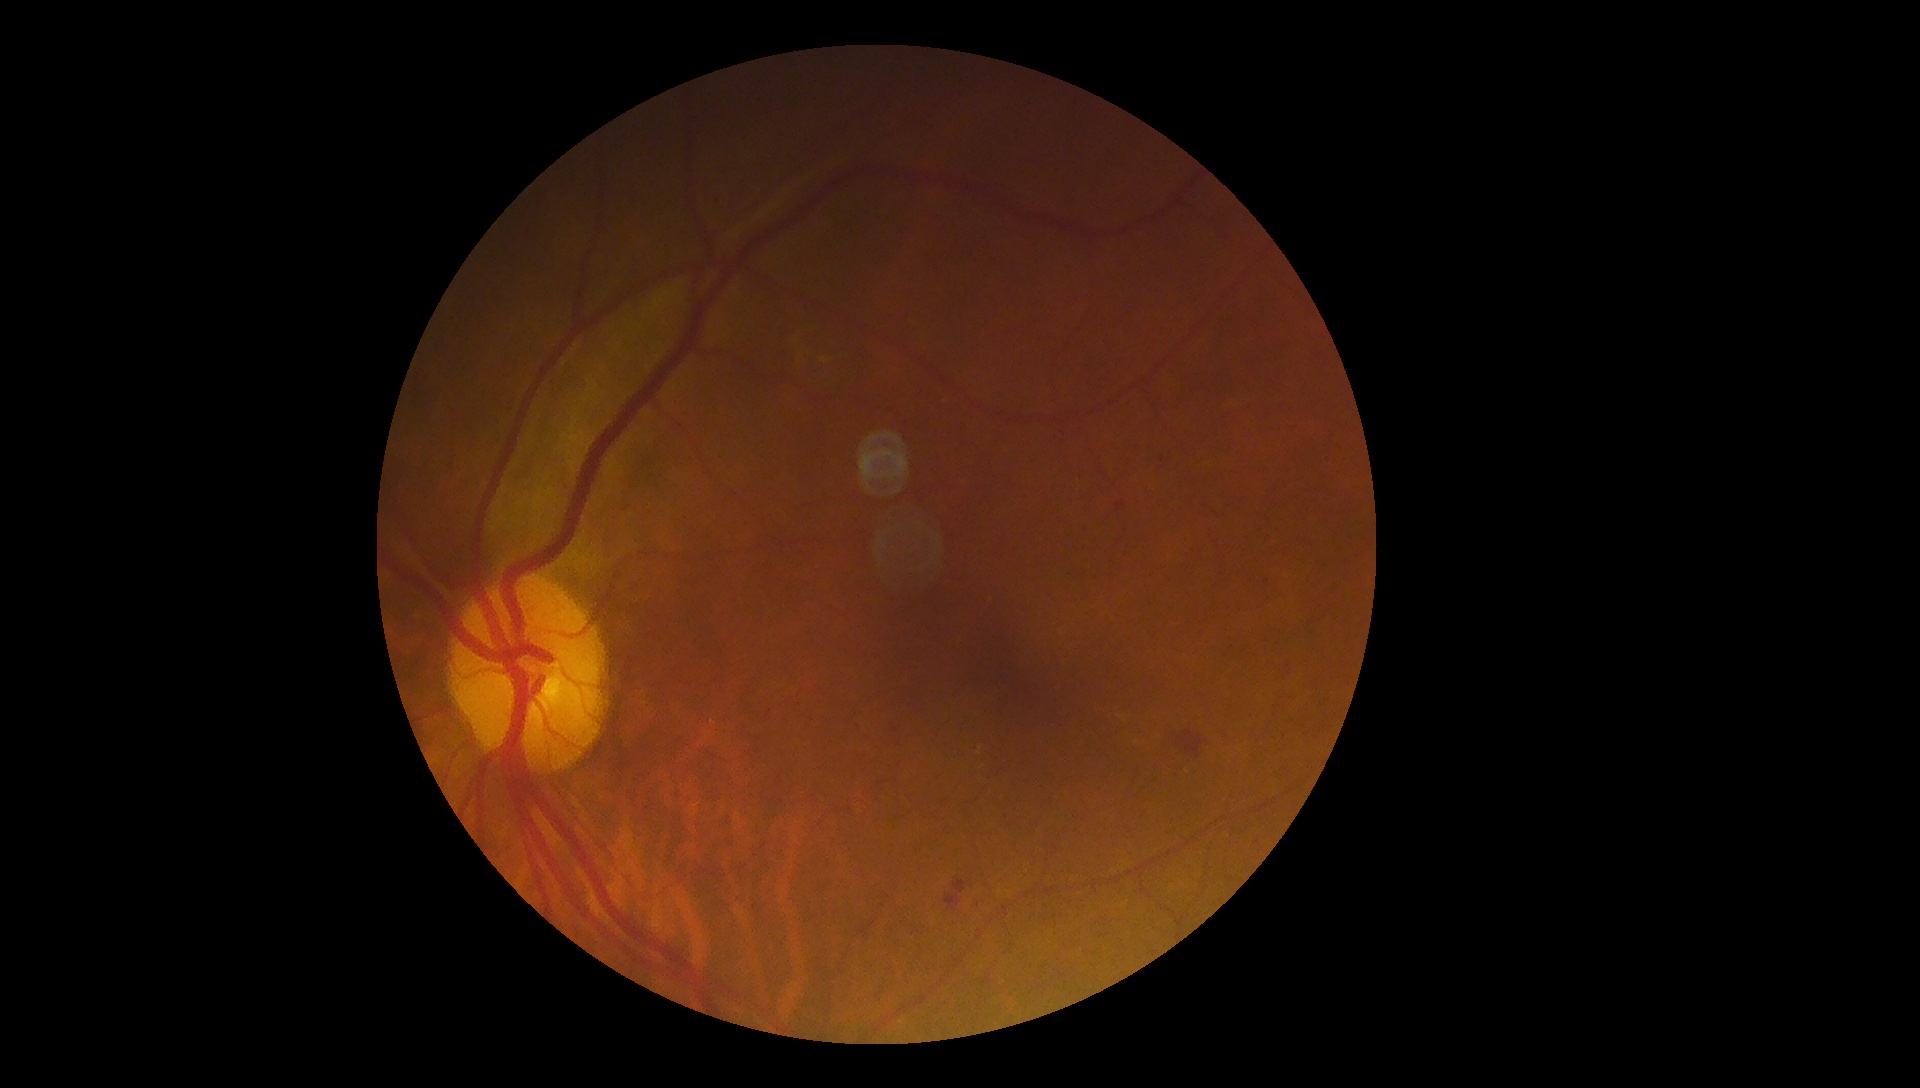
Retinopathy grade: 2.